Camera: Forus 3Nethra fundus camera · color fundus image
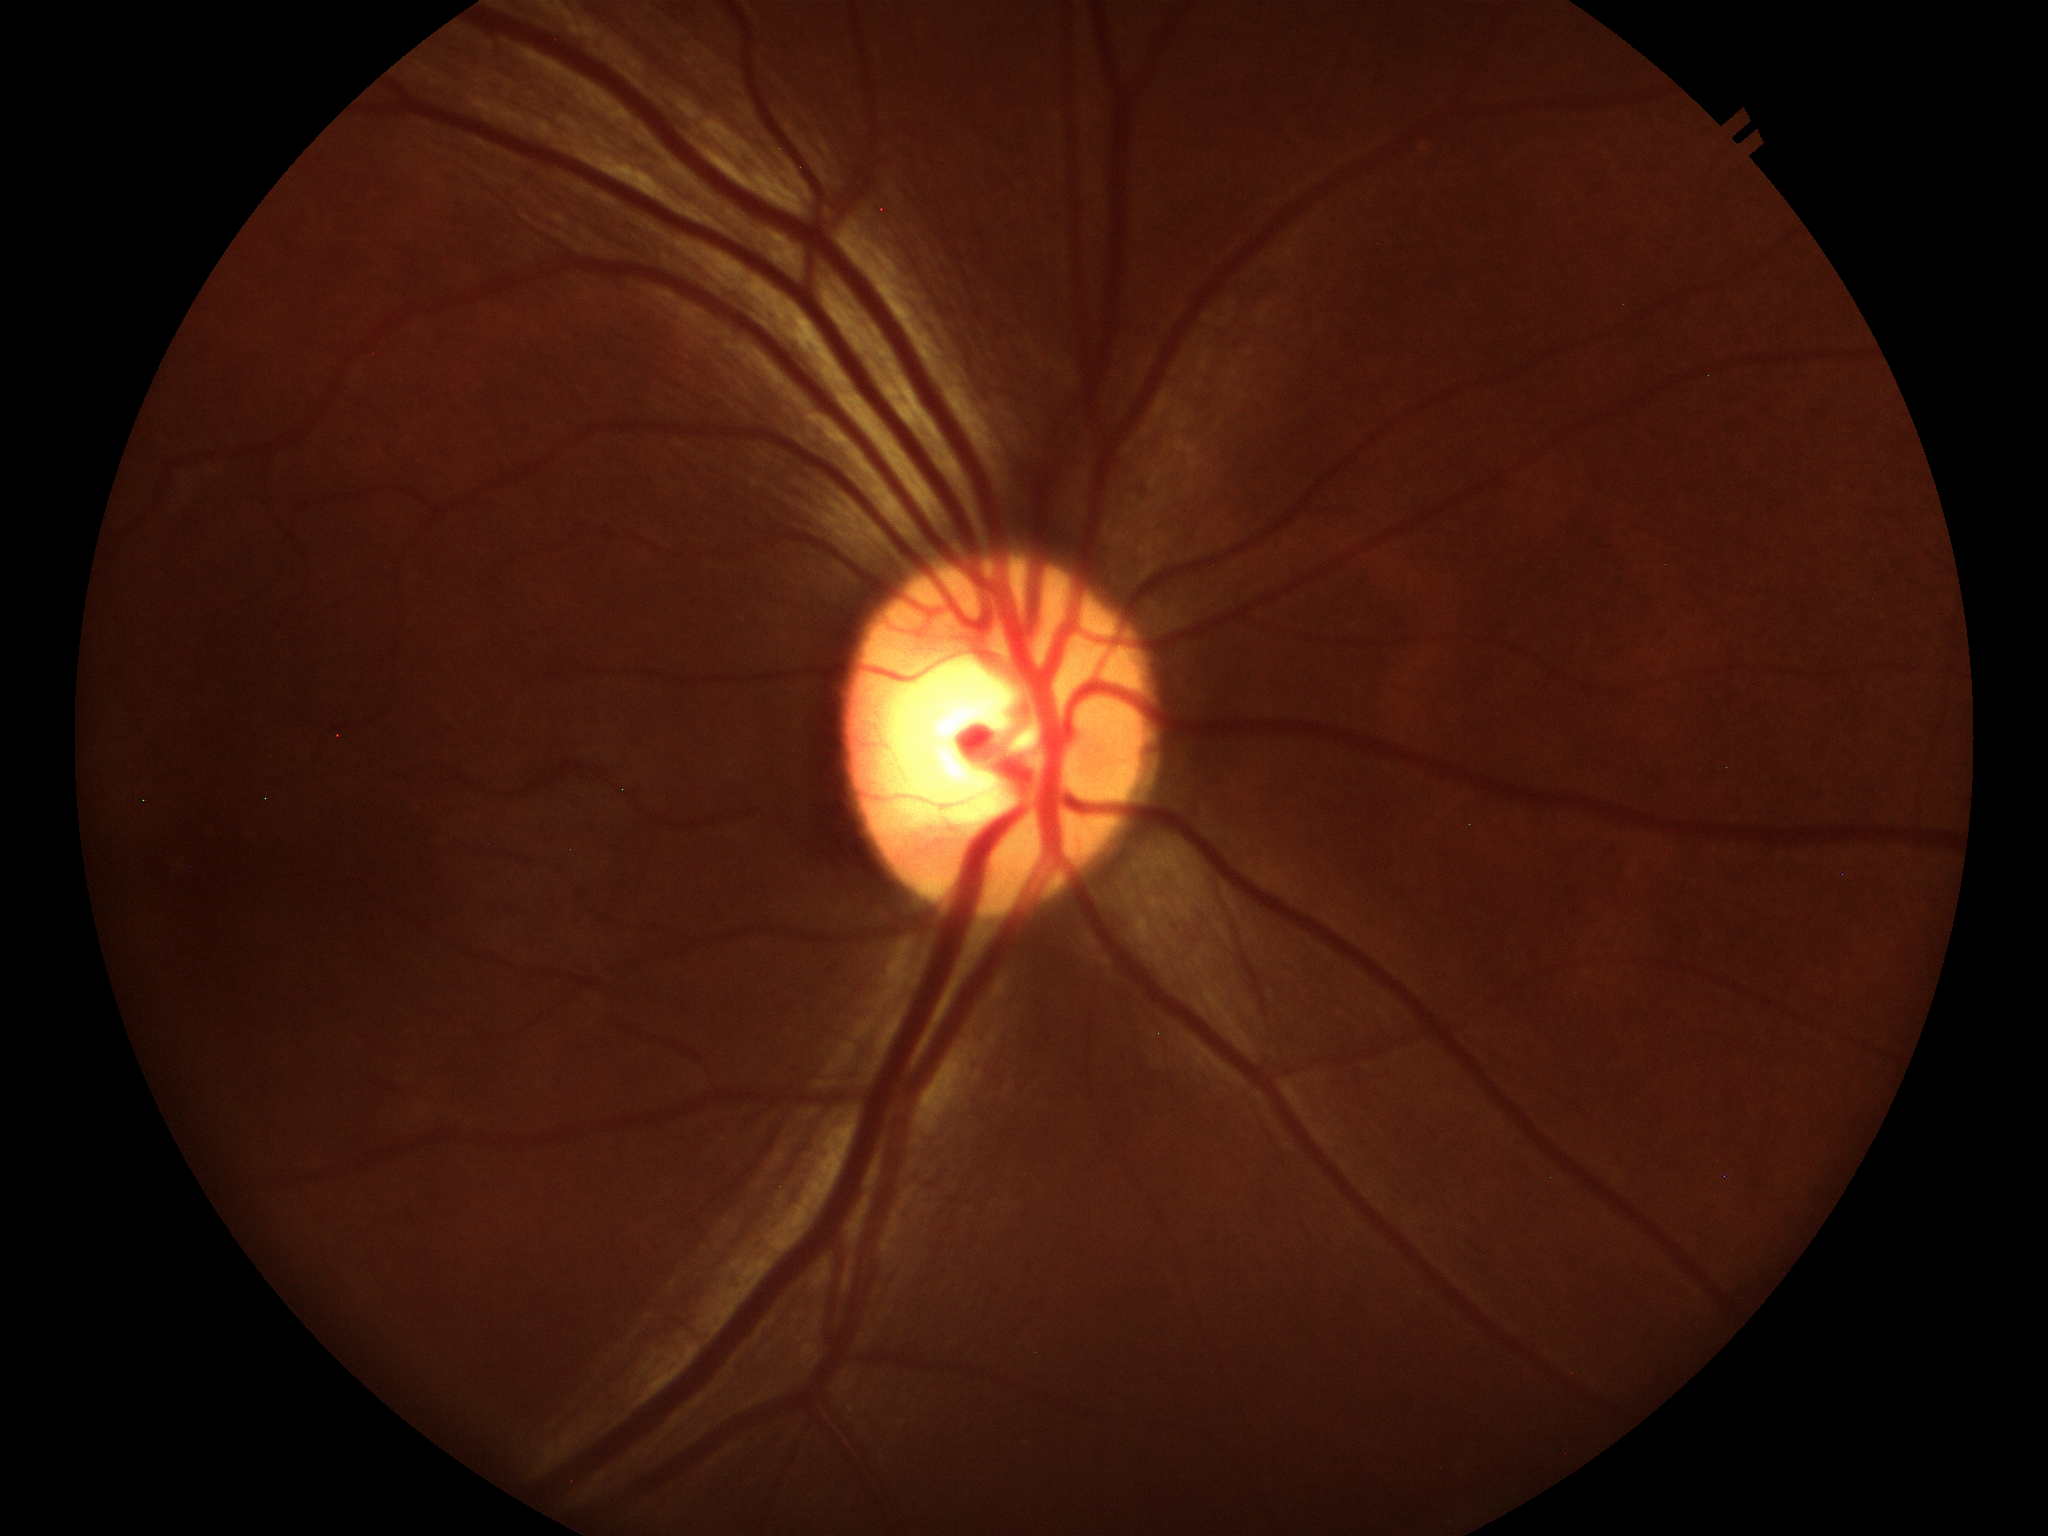 Not suspicious for glaucoma. Vertical cup-to-disc ratio: 0.55. Horizontal C/D ratio is 0.54.